FOV: 45 degrees.
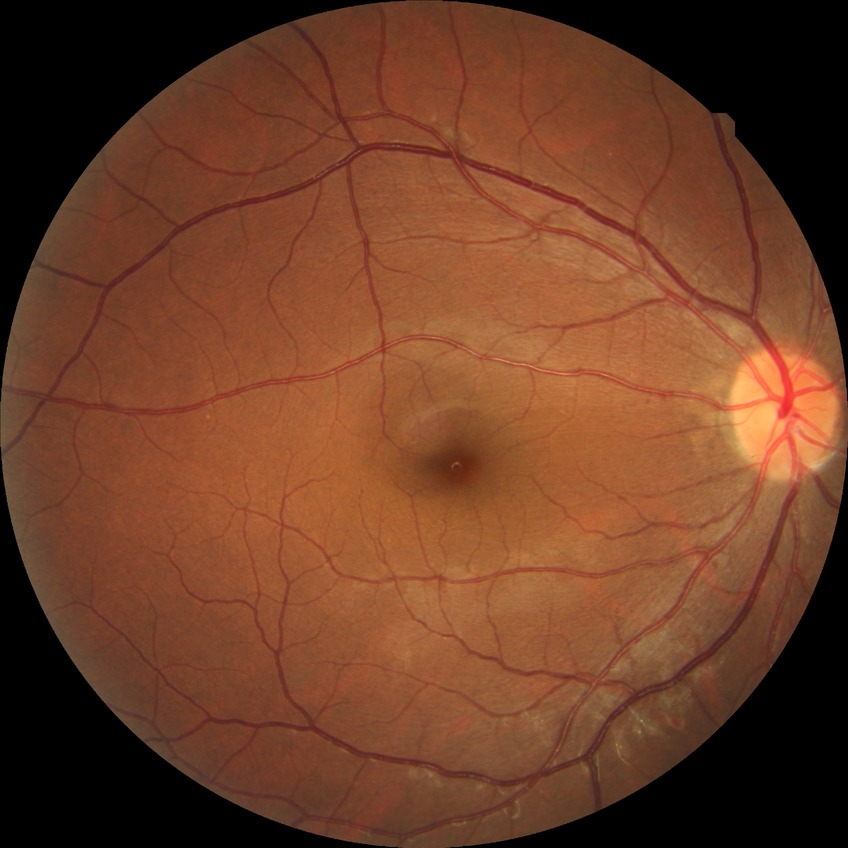 DR stage is NDR.